90-year-old patient. 30° FOV. Disc-centered field: 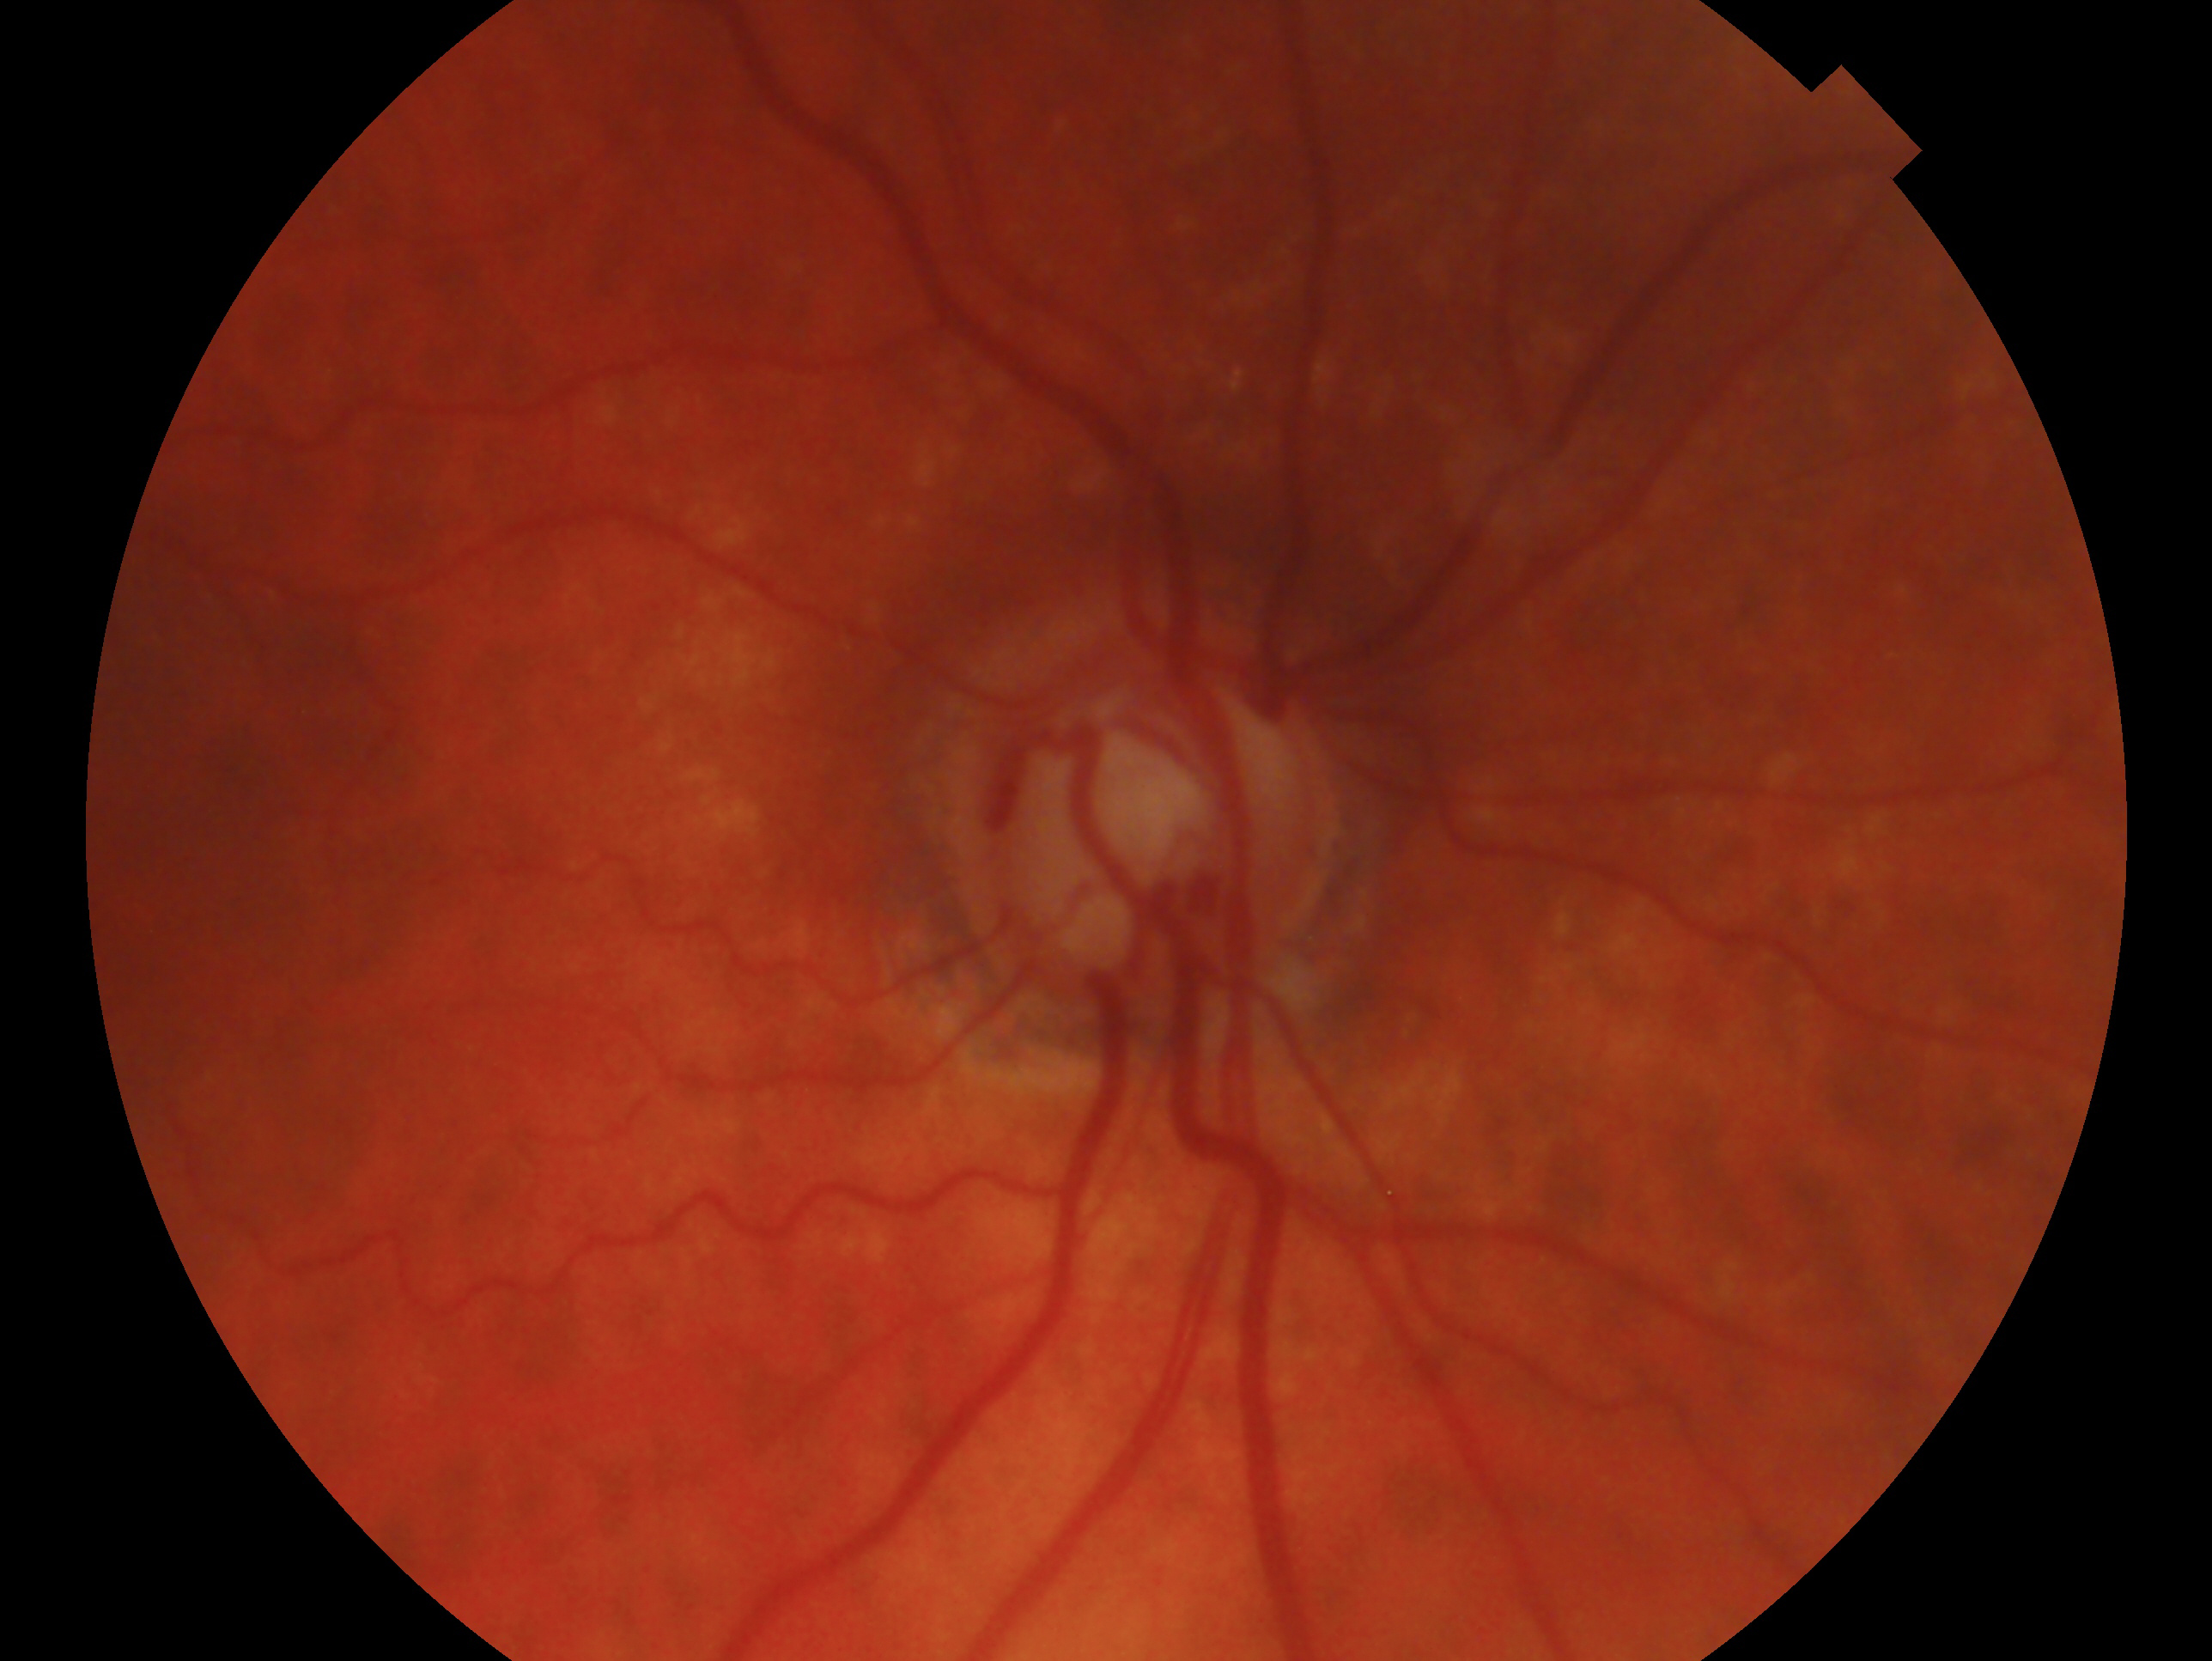

Imaged eye: right eye. Diagnosis: glaucomatous optic neuropathy — clinically confirmed glaucoma with characteristic optic nerve damage.